2089x1764. Fundus photo:
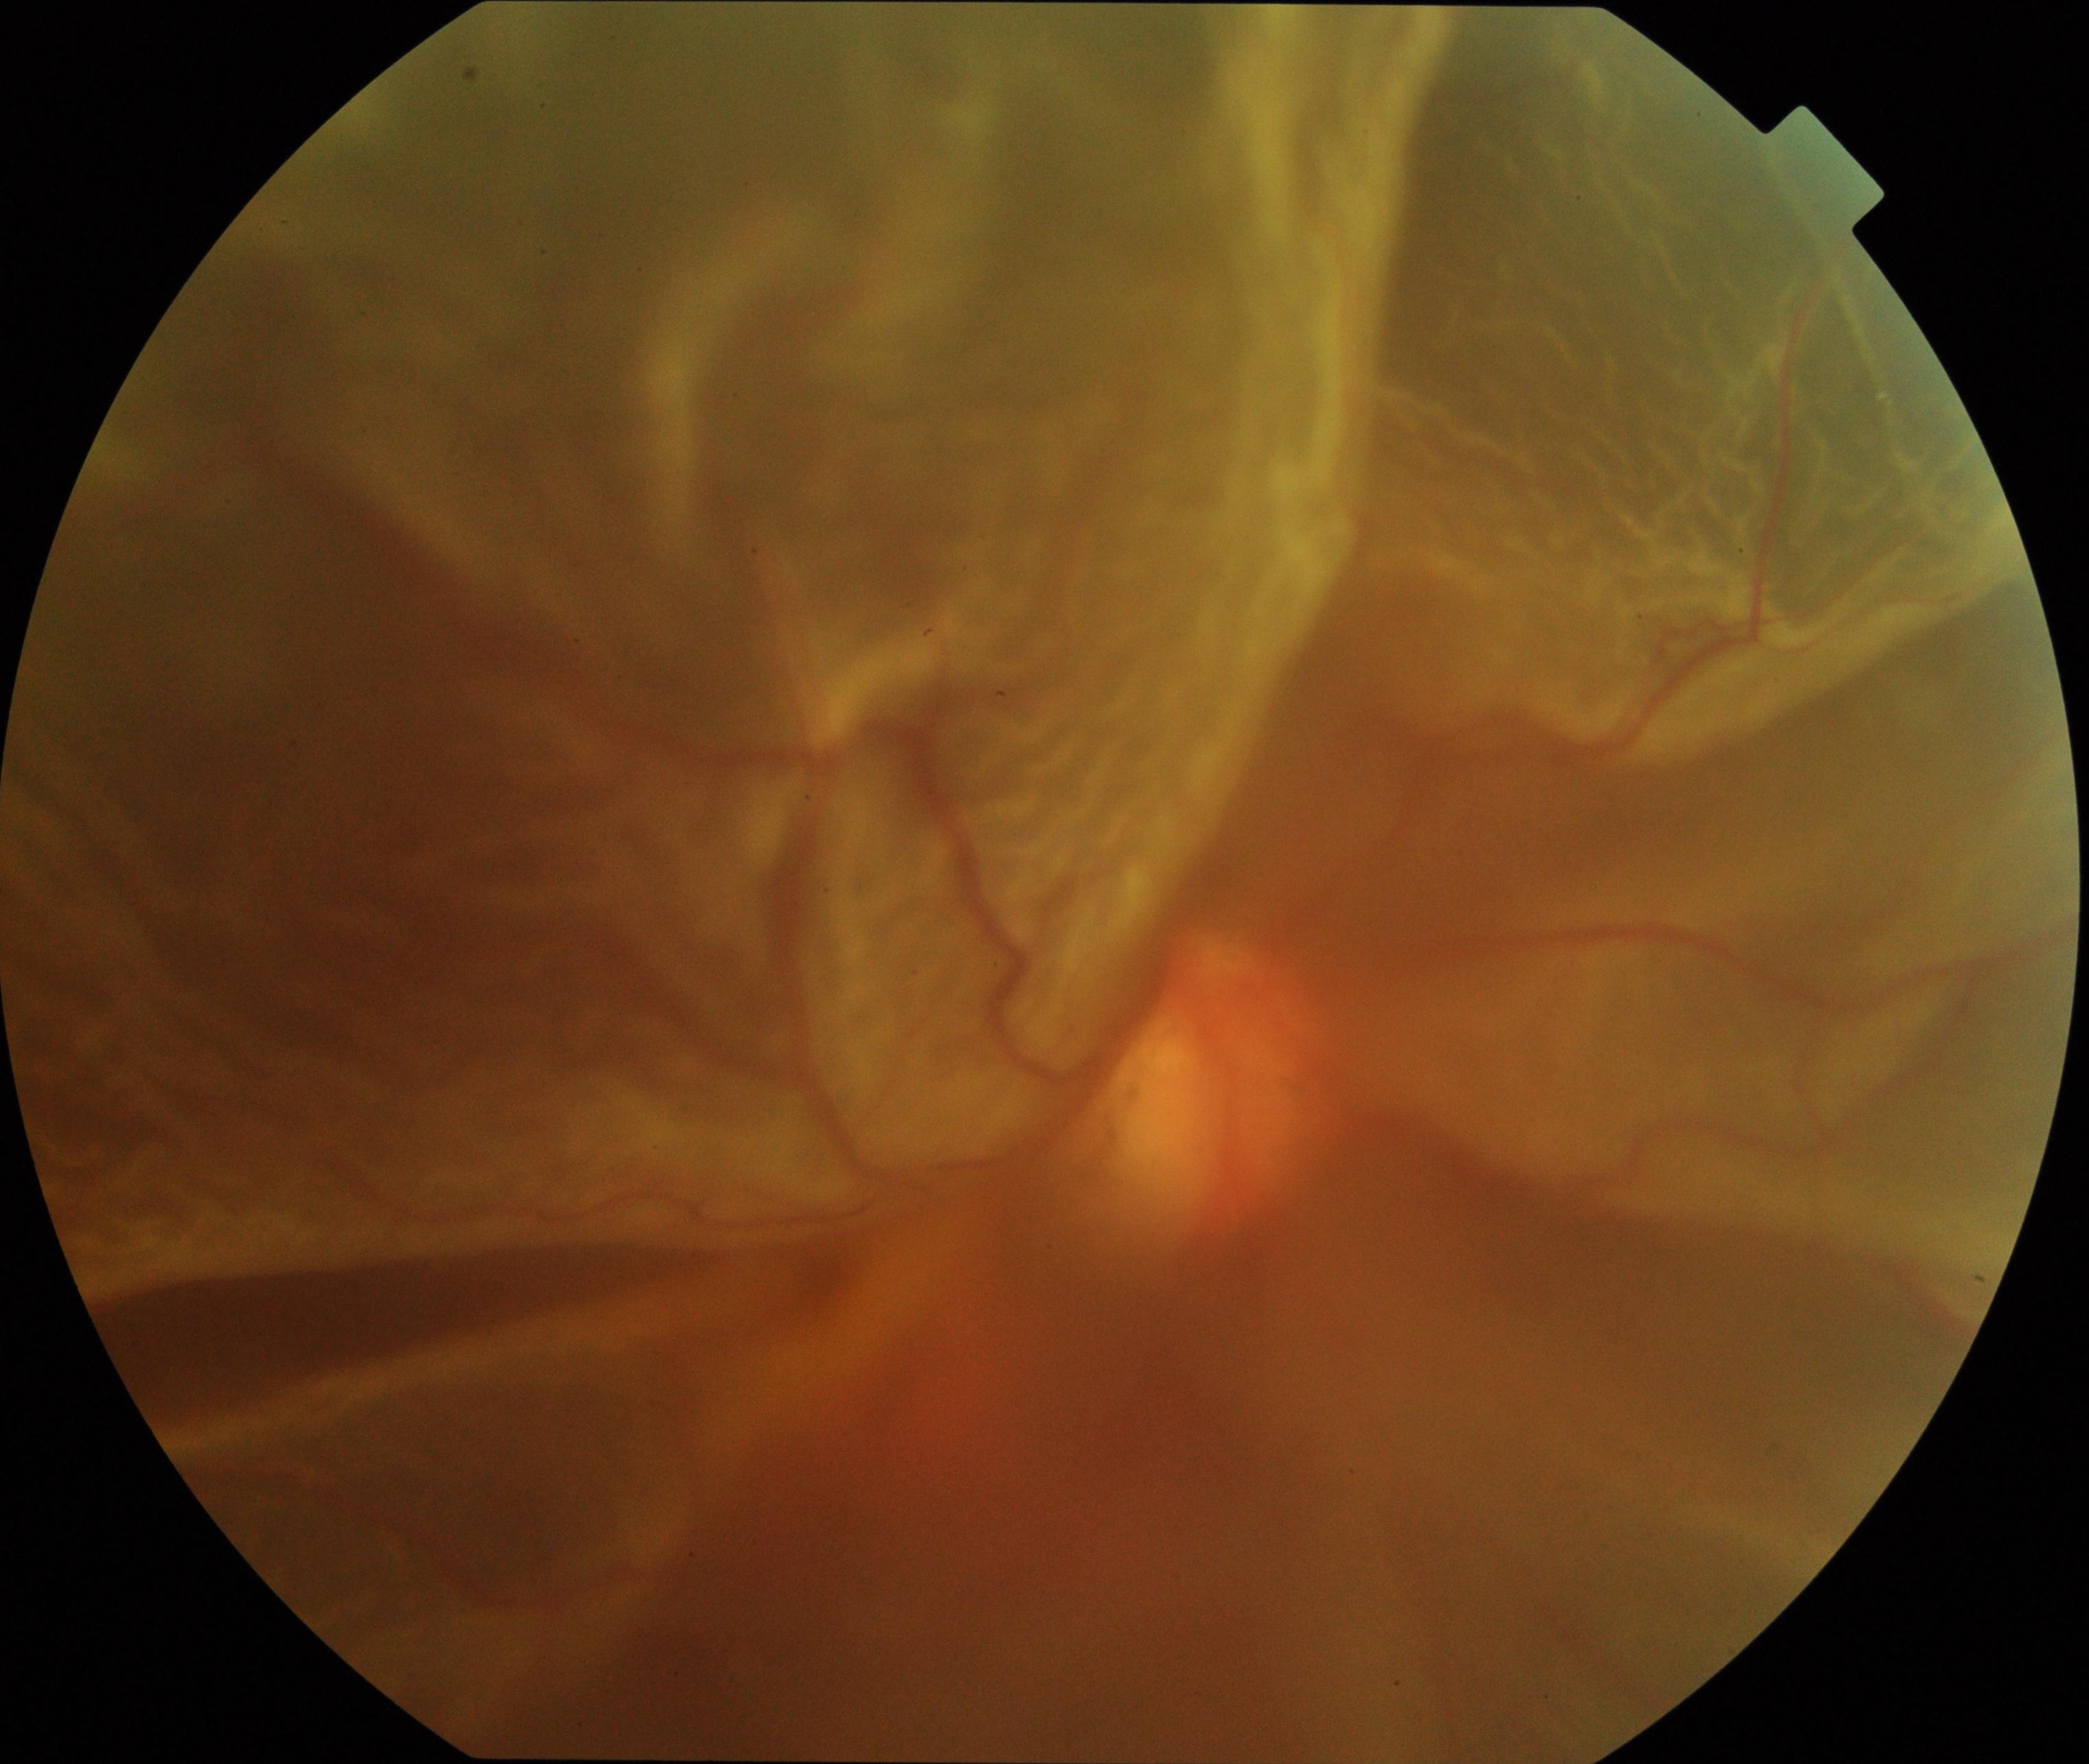

The image shows rhegmatogenous retinal detachment.